Pupil-dilated; posterior pole field covering the optic disc and macula — 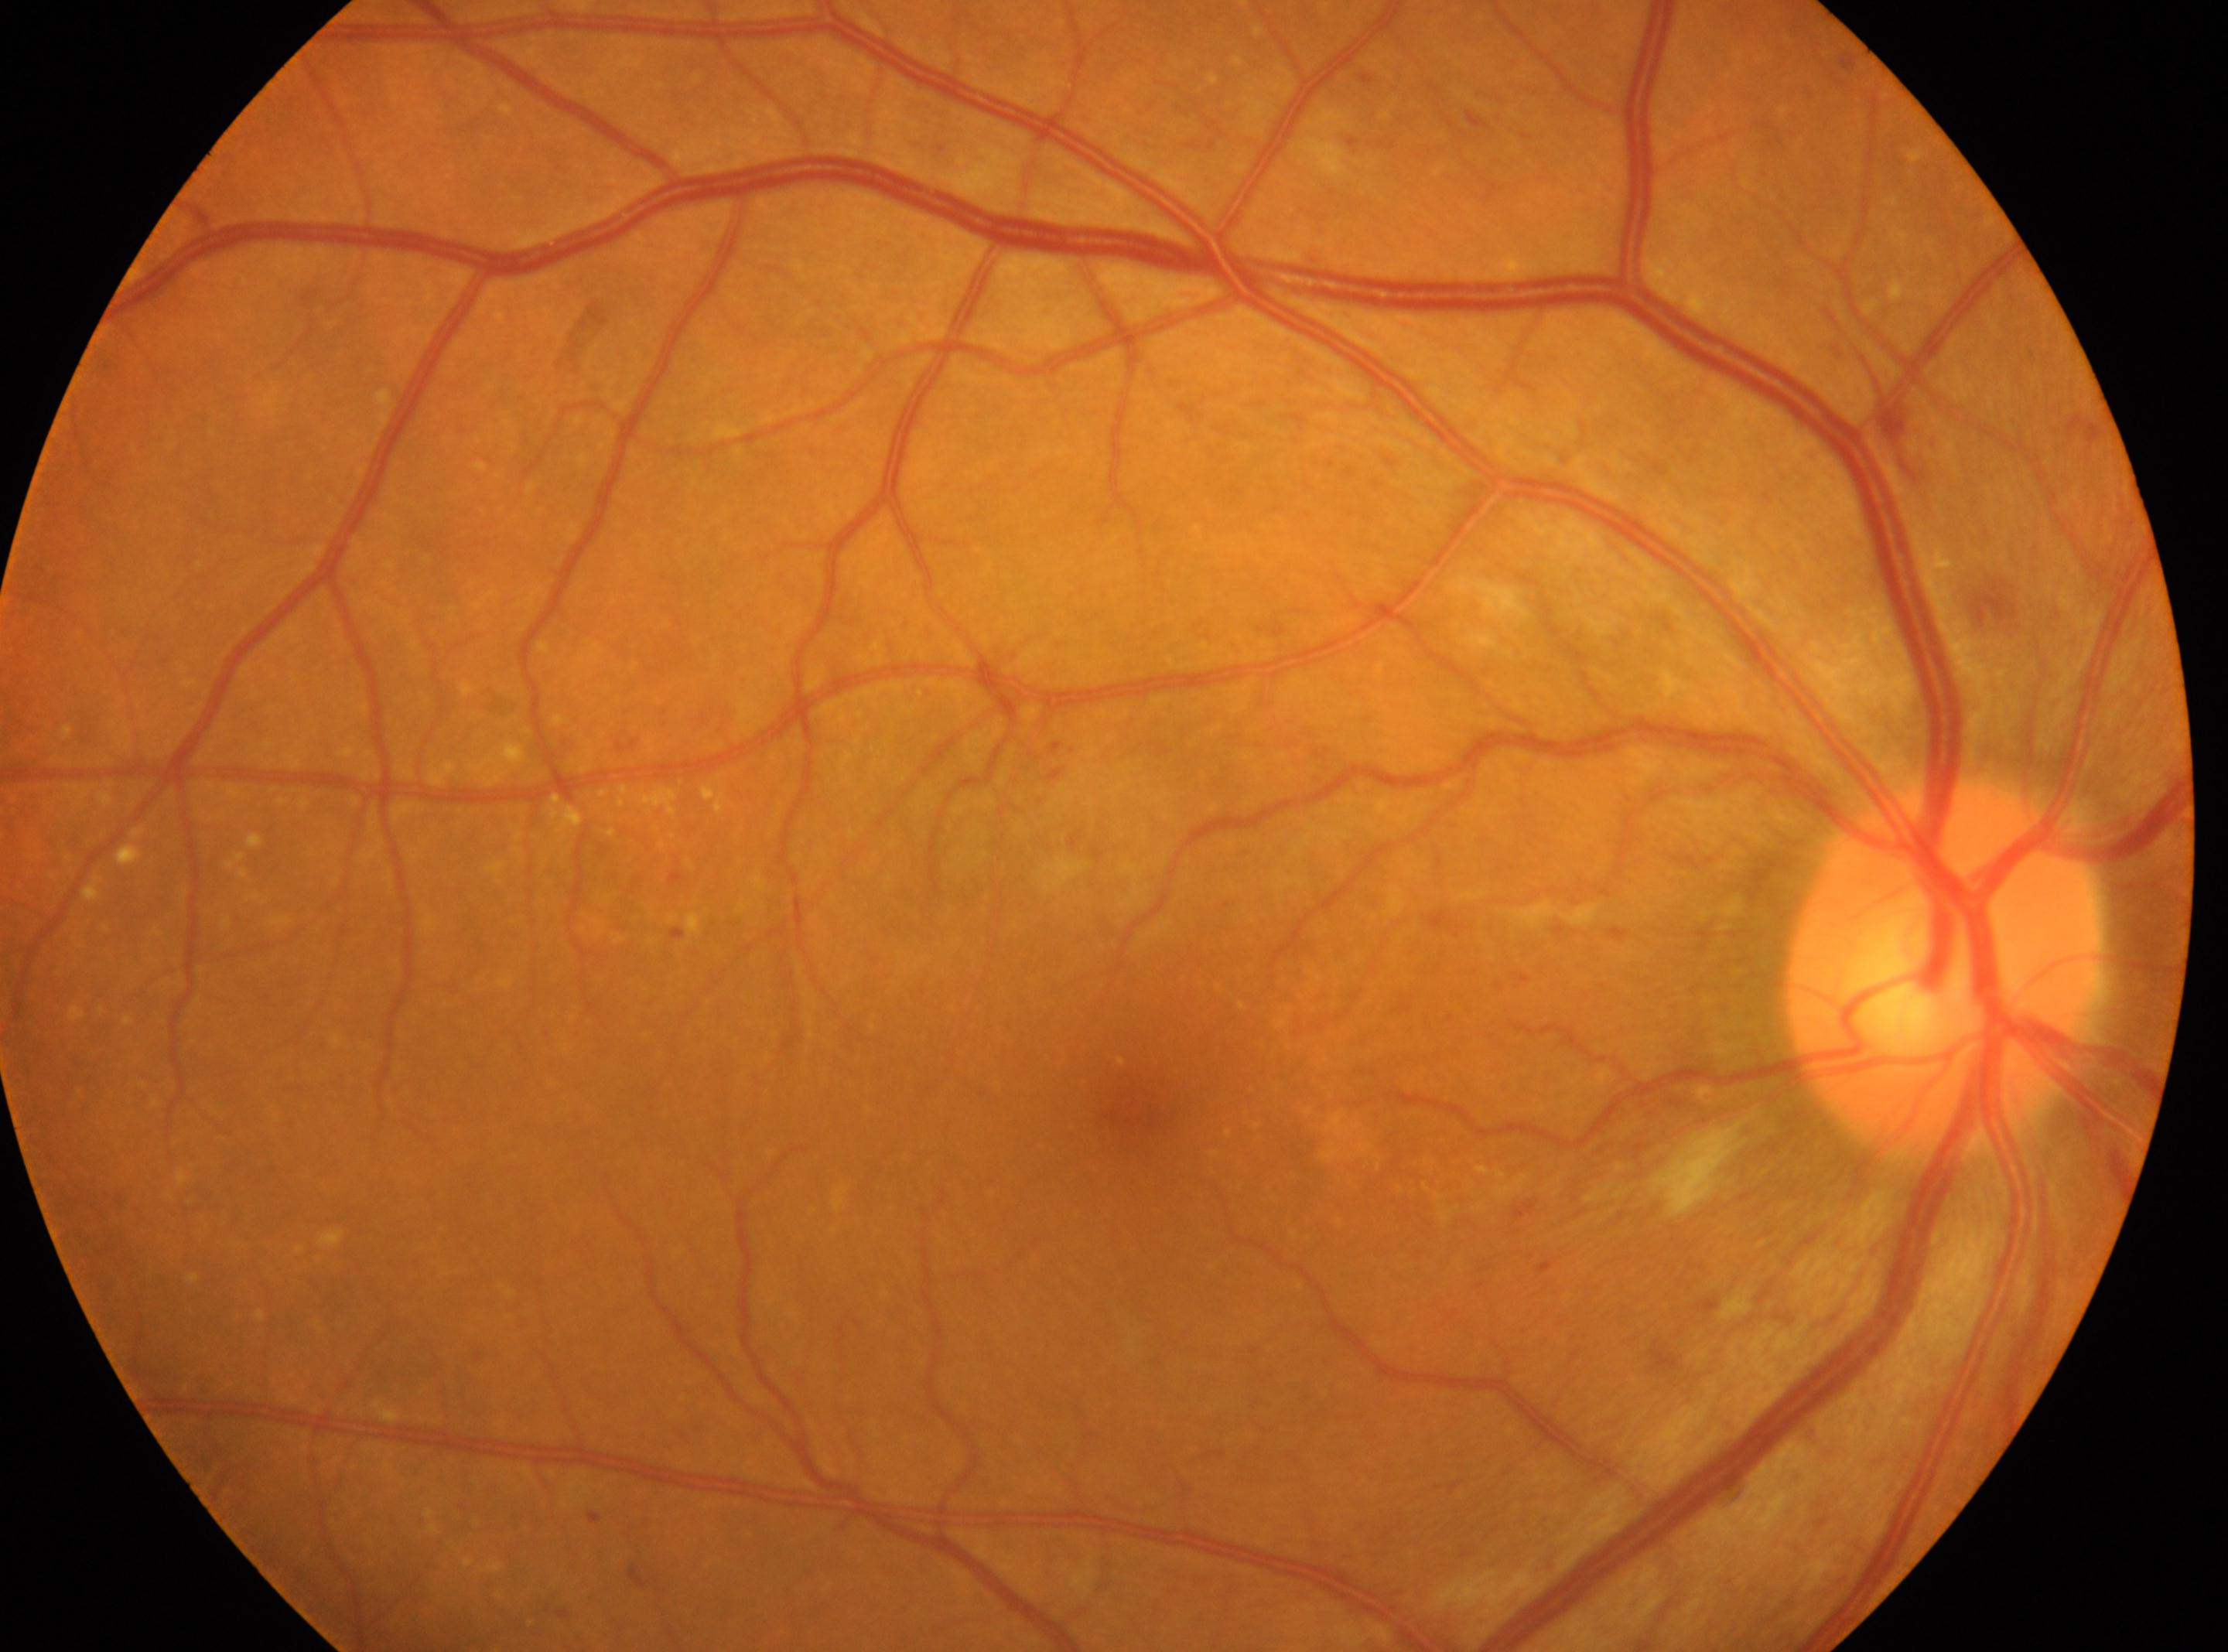
This is the right eye. The macula center is at (x=1133, y=1106). Optic disk located at (x=1943, y=970). Diabetic retinopathy severity: grade 2 (moderate NPDR).